CFP.
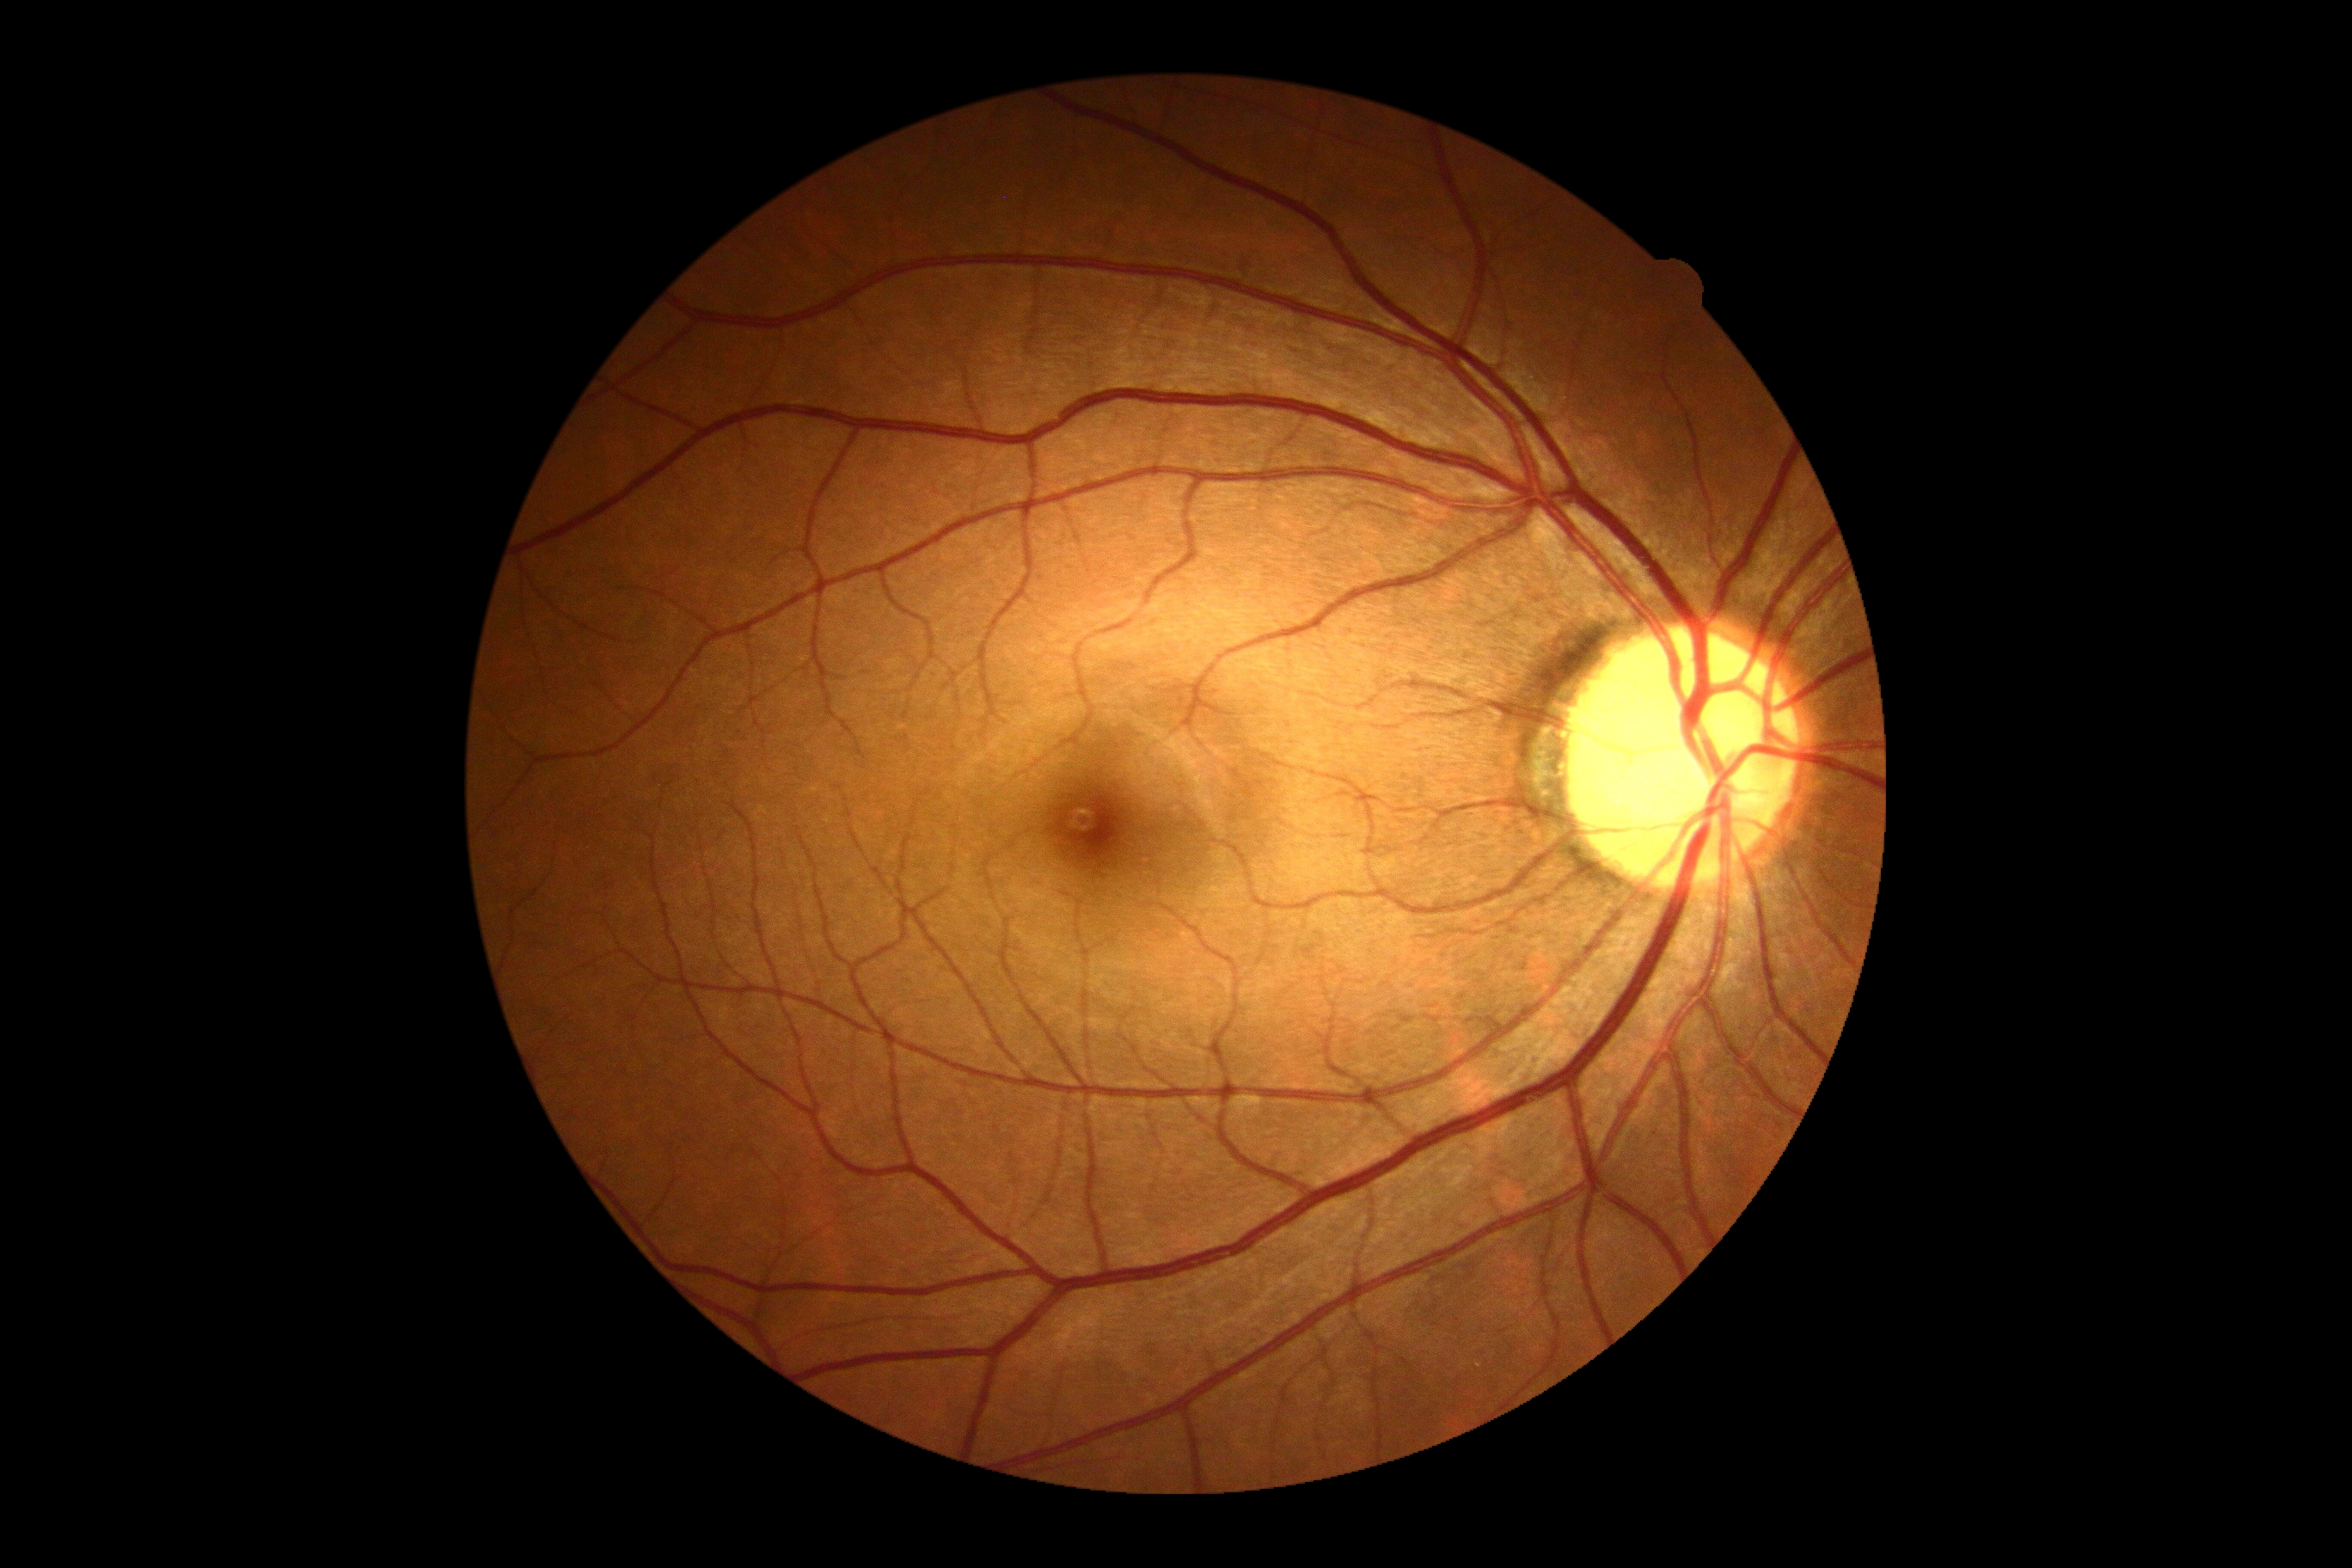 Diabetic retinopathy (DR) is no apparent retinopathy (grade 0).